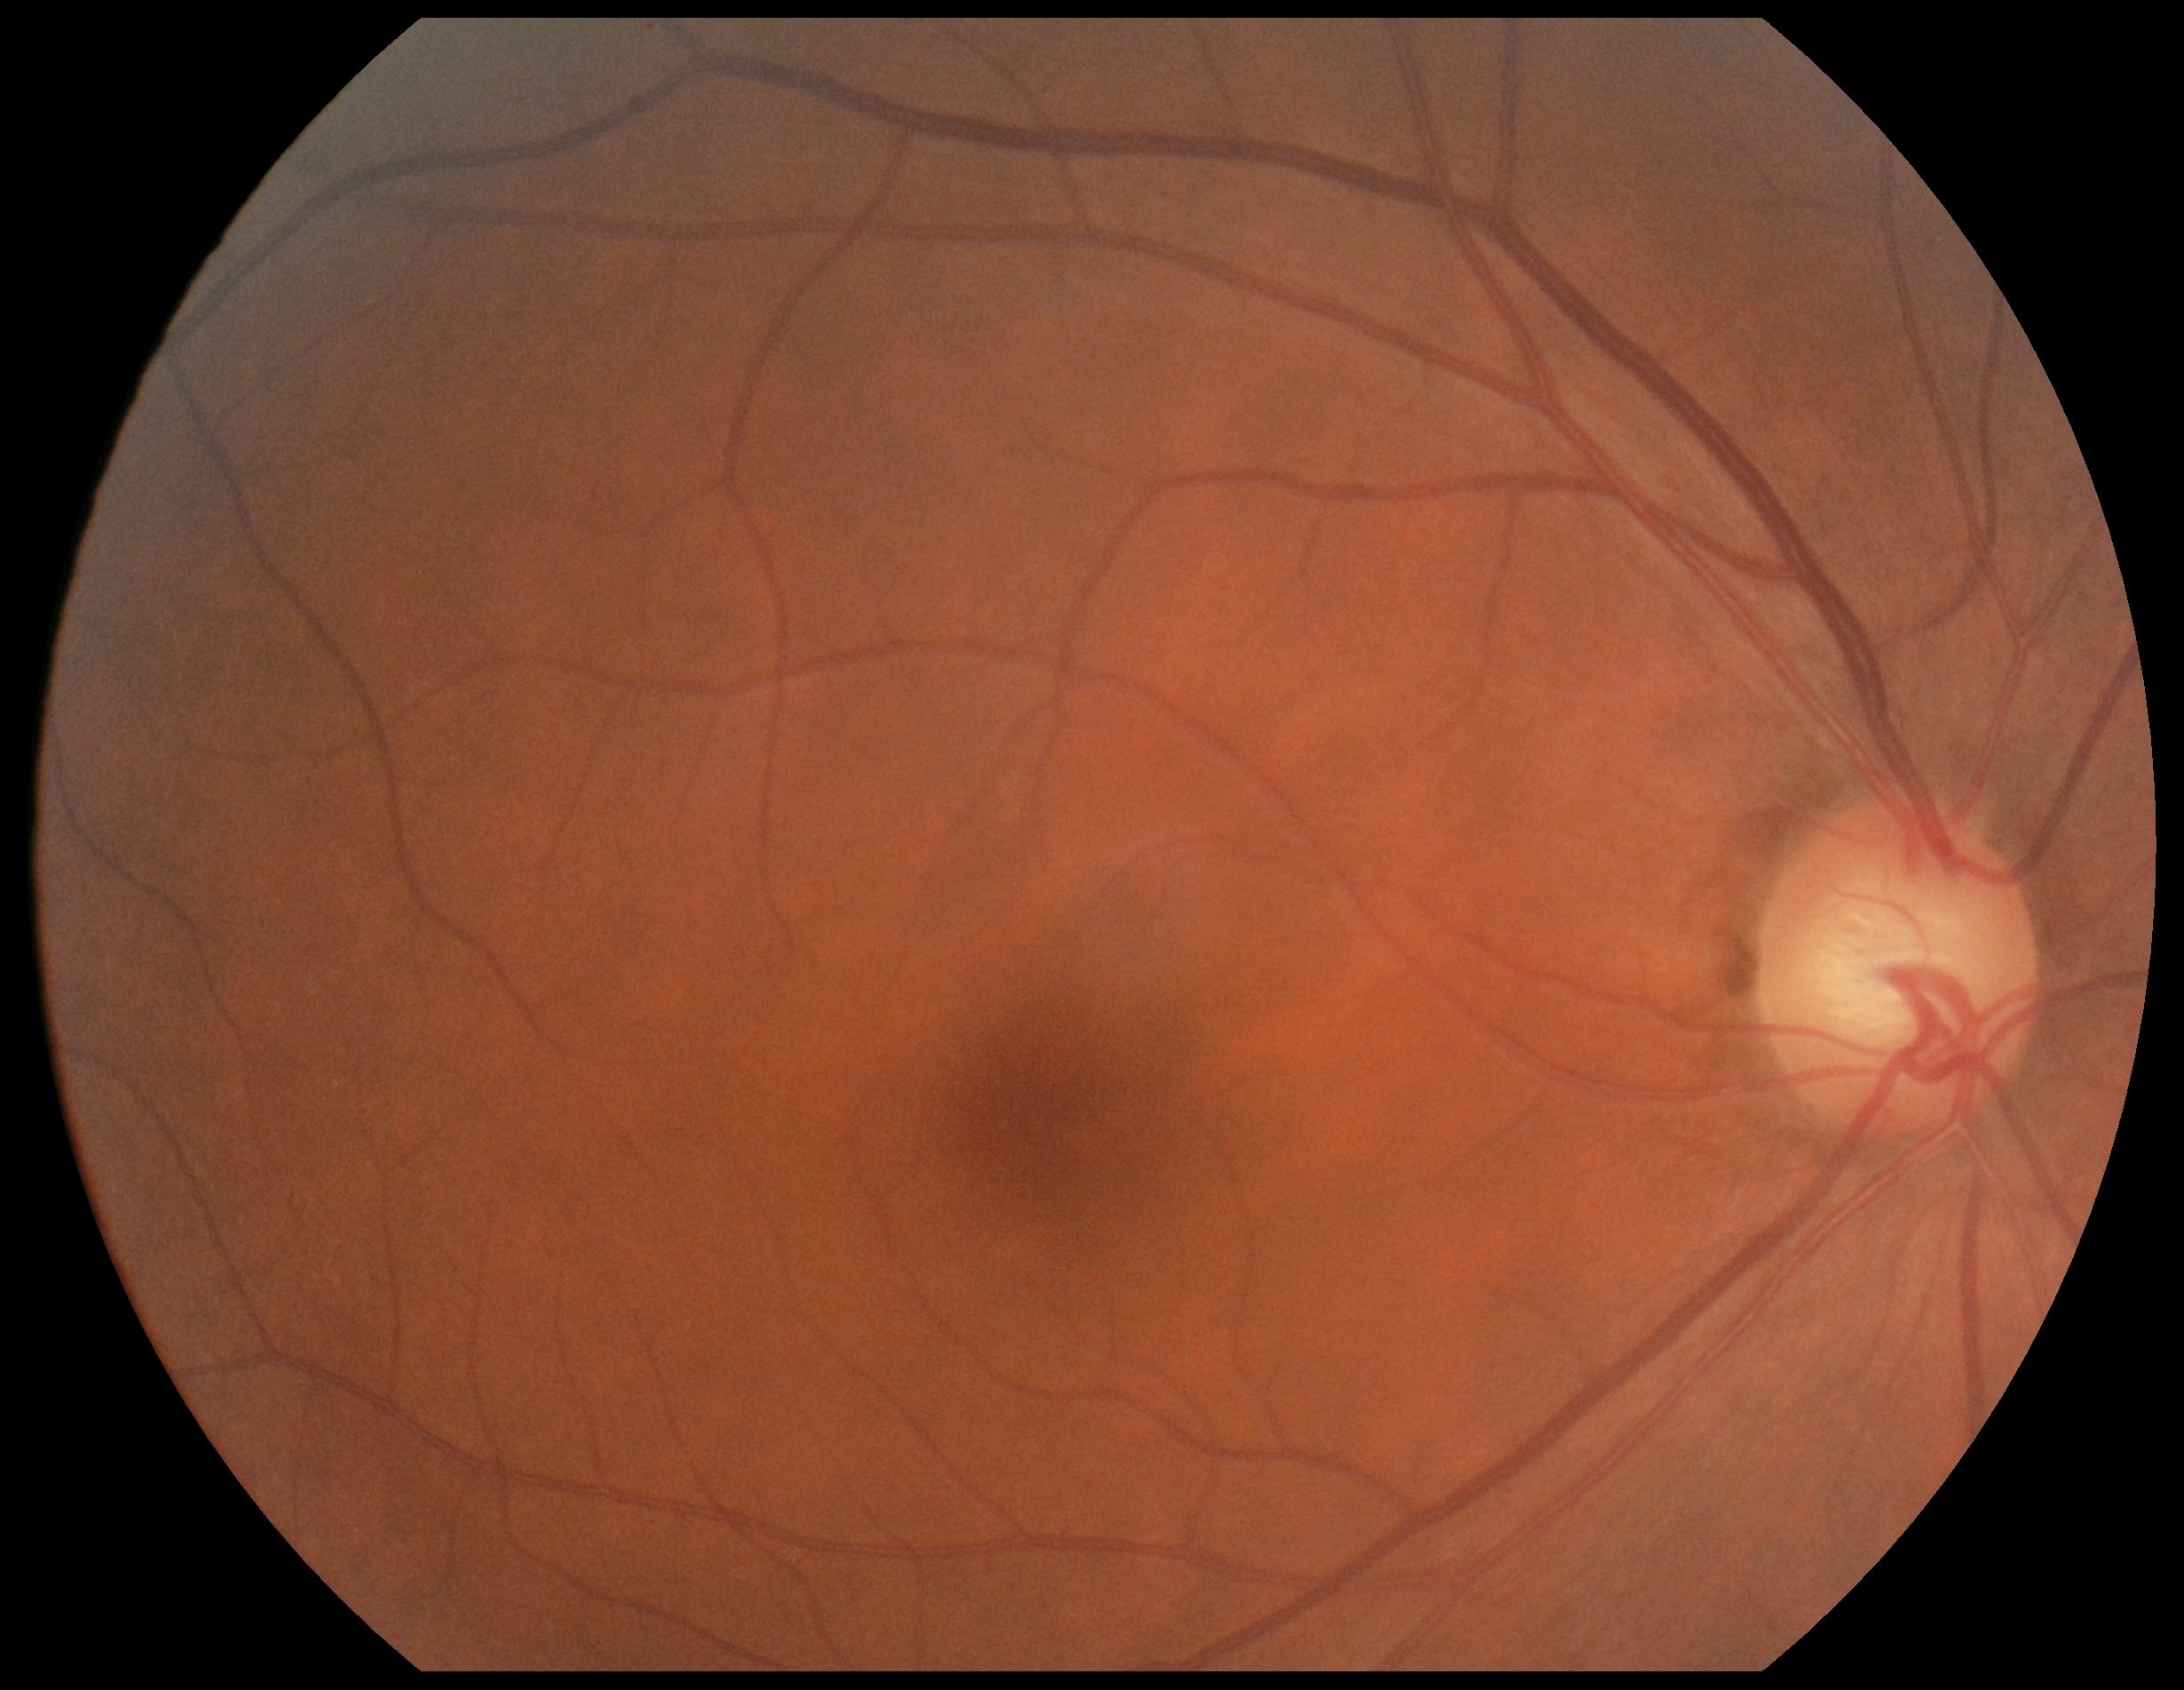

diabetic retinopathy severity: grade 0 (no apparent retinopathy) — no visible signs of diabetic retinopathy; DR impression: no signs of DR.